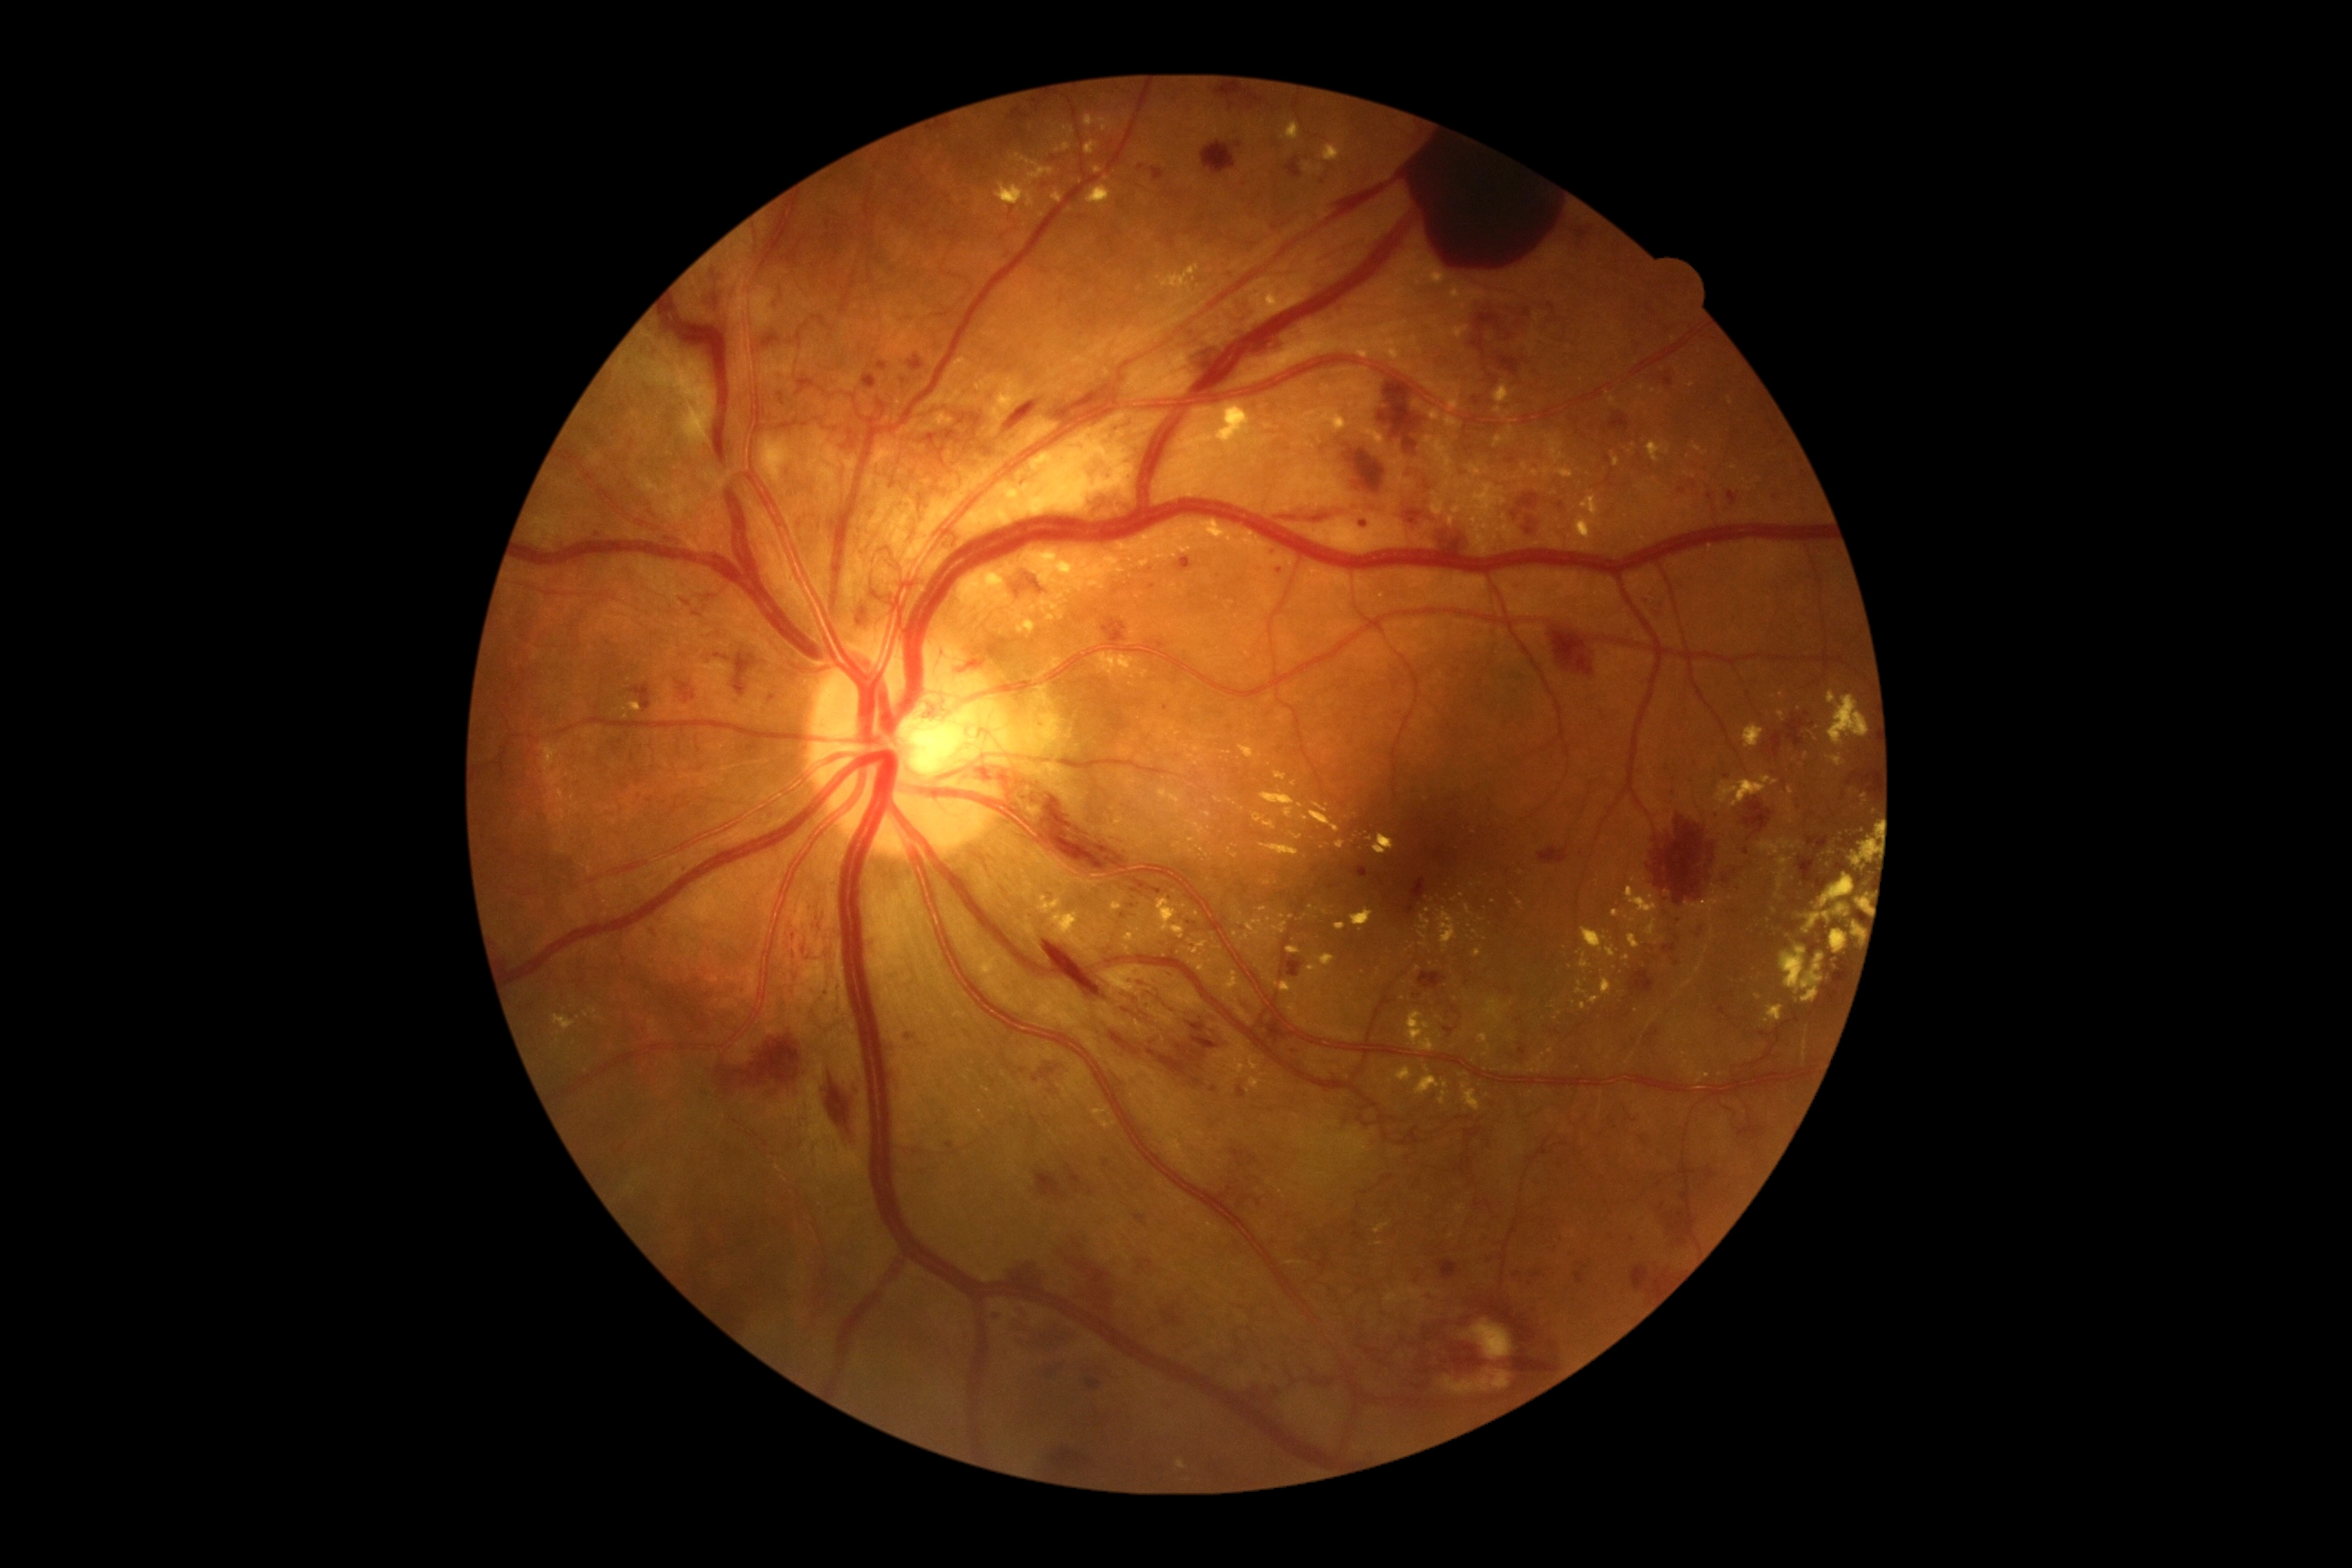
{"partial": true, "dr_grade": 4, "dr_grade_name": "PDR", "lesions": {"he": [[1257, 1200, 1260, 1208], [1173, 1335, 1202, 1355], [957, 765, 1171, 905], [1398, 467, 1436, 529], [908, 357, 925, 371], [1712, 812, 1720, 819], [1003, 1259, 1052, 1291], [1202, 142, 1237, 175], [1609, 411, 1631, 433], [1518, 1046, 1525, 1055], [1489, 375, 1500, 386], [1161, 1396, 1177, 1416], [1663, 371, 1672, 387], [1645, 1030, 1660, 1043], [1188, 941, 1199, 948], [1636, 589, 1665, 620]], "he_small_approx": [[1813, 725], [1562, 507]], "ex": [[1092, 1104, 1117, 1130], [1464, 905, 1473, 916], [1623, 888, 1660, 937], [1186, 522, 1284, 565], [1239, 745, 1255, 758], [594, 1017, 603, 1021], [1803, 1039, 1808, 1061], [1084, 115, 1113, 132], [1302, 409, 1349, 435], [1306, 164, 1313, 173], [1253, 814, 1277, 830], [1052, 191, 1064, 204]], "ex_small_approx": [[1697, 449], [1107, 179], [1522, 874], [1642, 388], [1693, 385], [1324, 848], [1207, 815]]}}